FOV 35° before cropping, dilated pupil, color fundus photograph centered on the optic disc
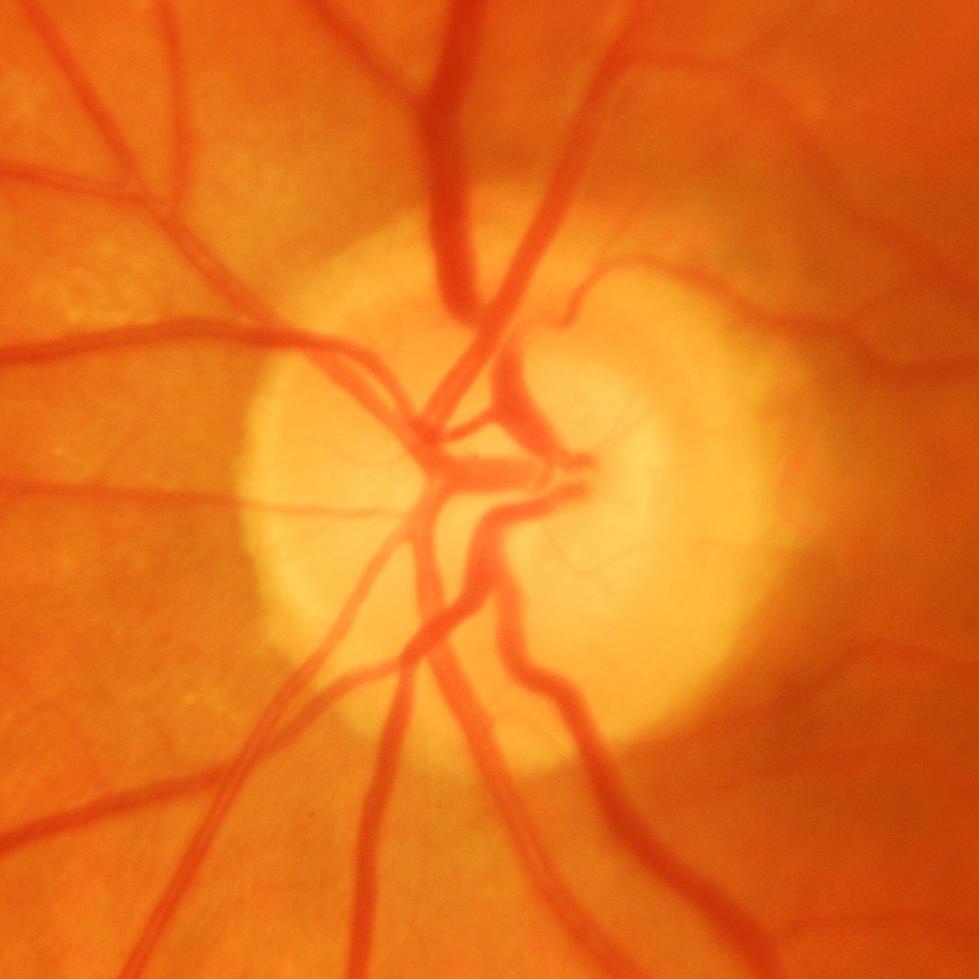
Evidence of glaucoma.